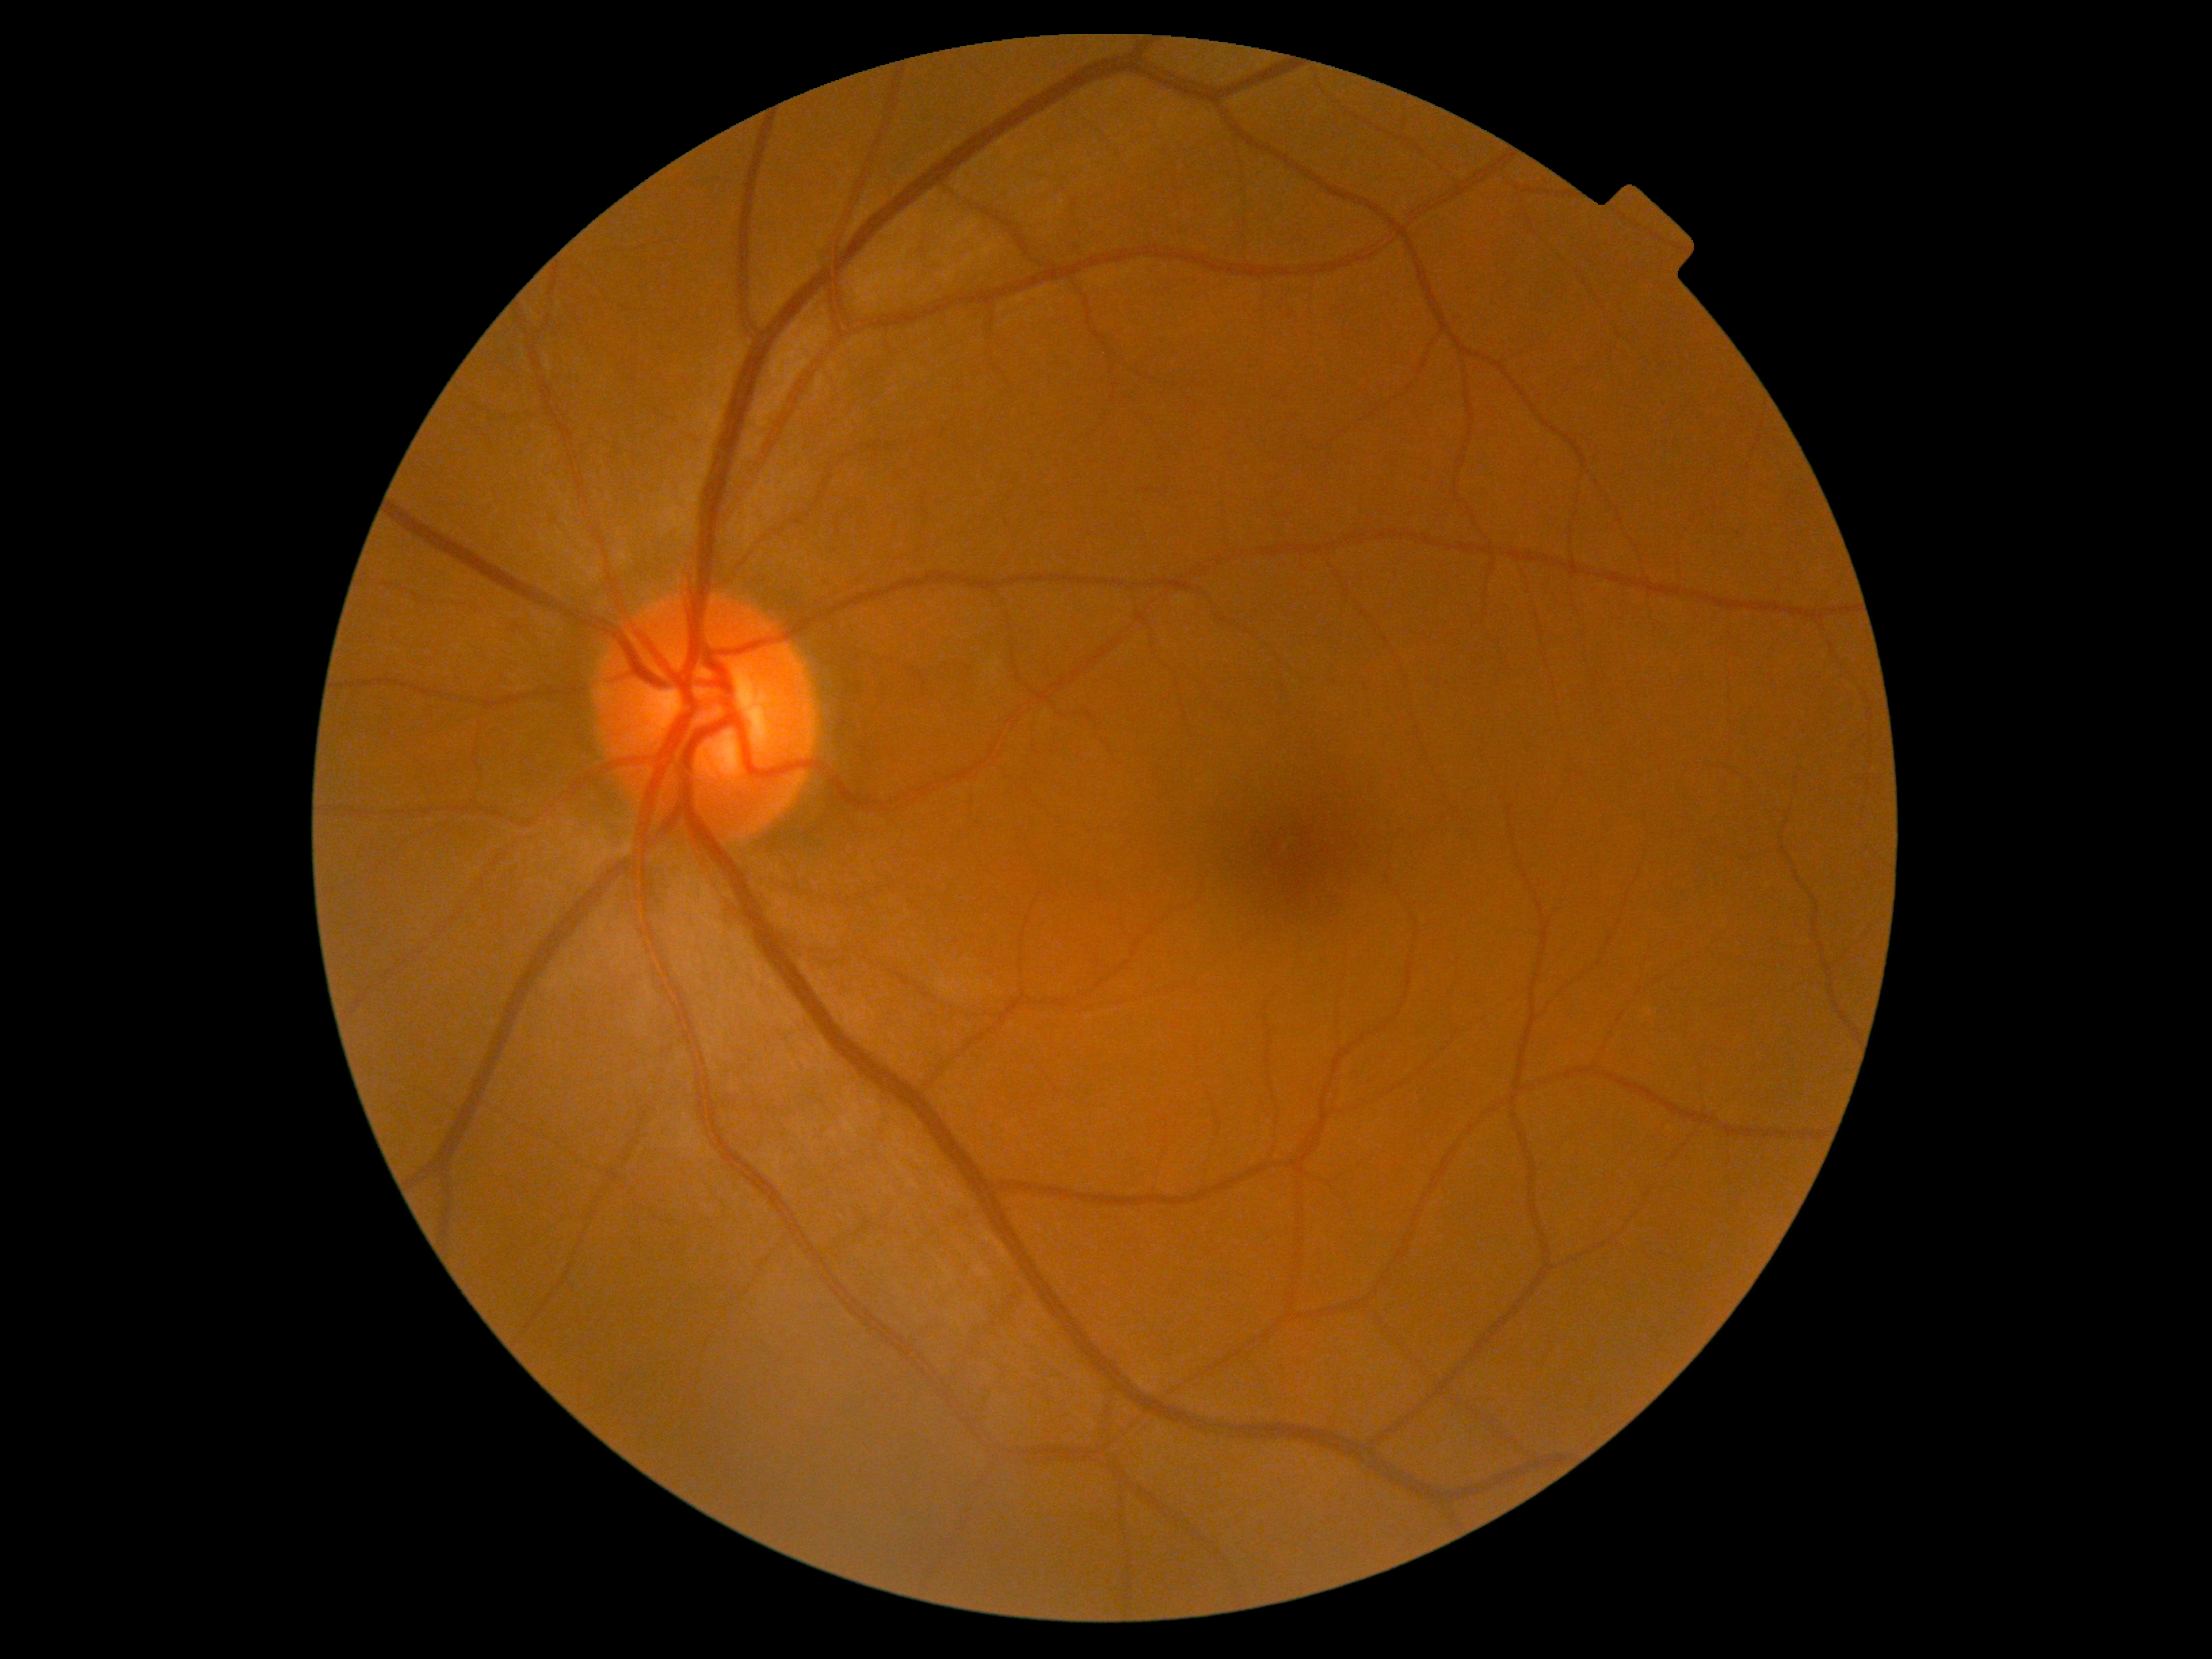

Diabetic retinopathy (DR) is grade 0 (no apparent retinopathy).